Retinal fundus photograph. Camera: Remidio Fundus on Phone. 1659x2212.
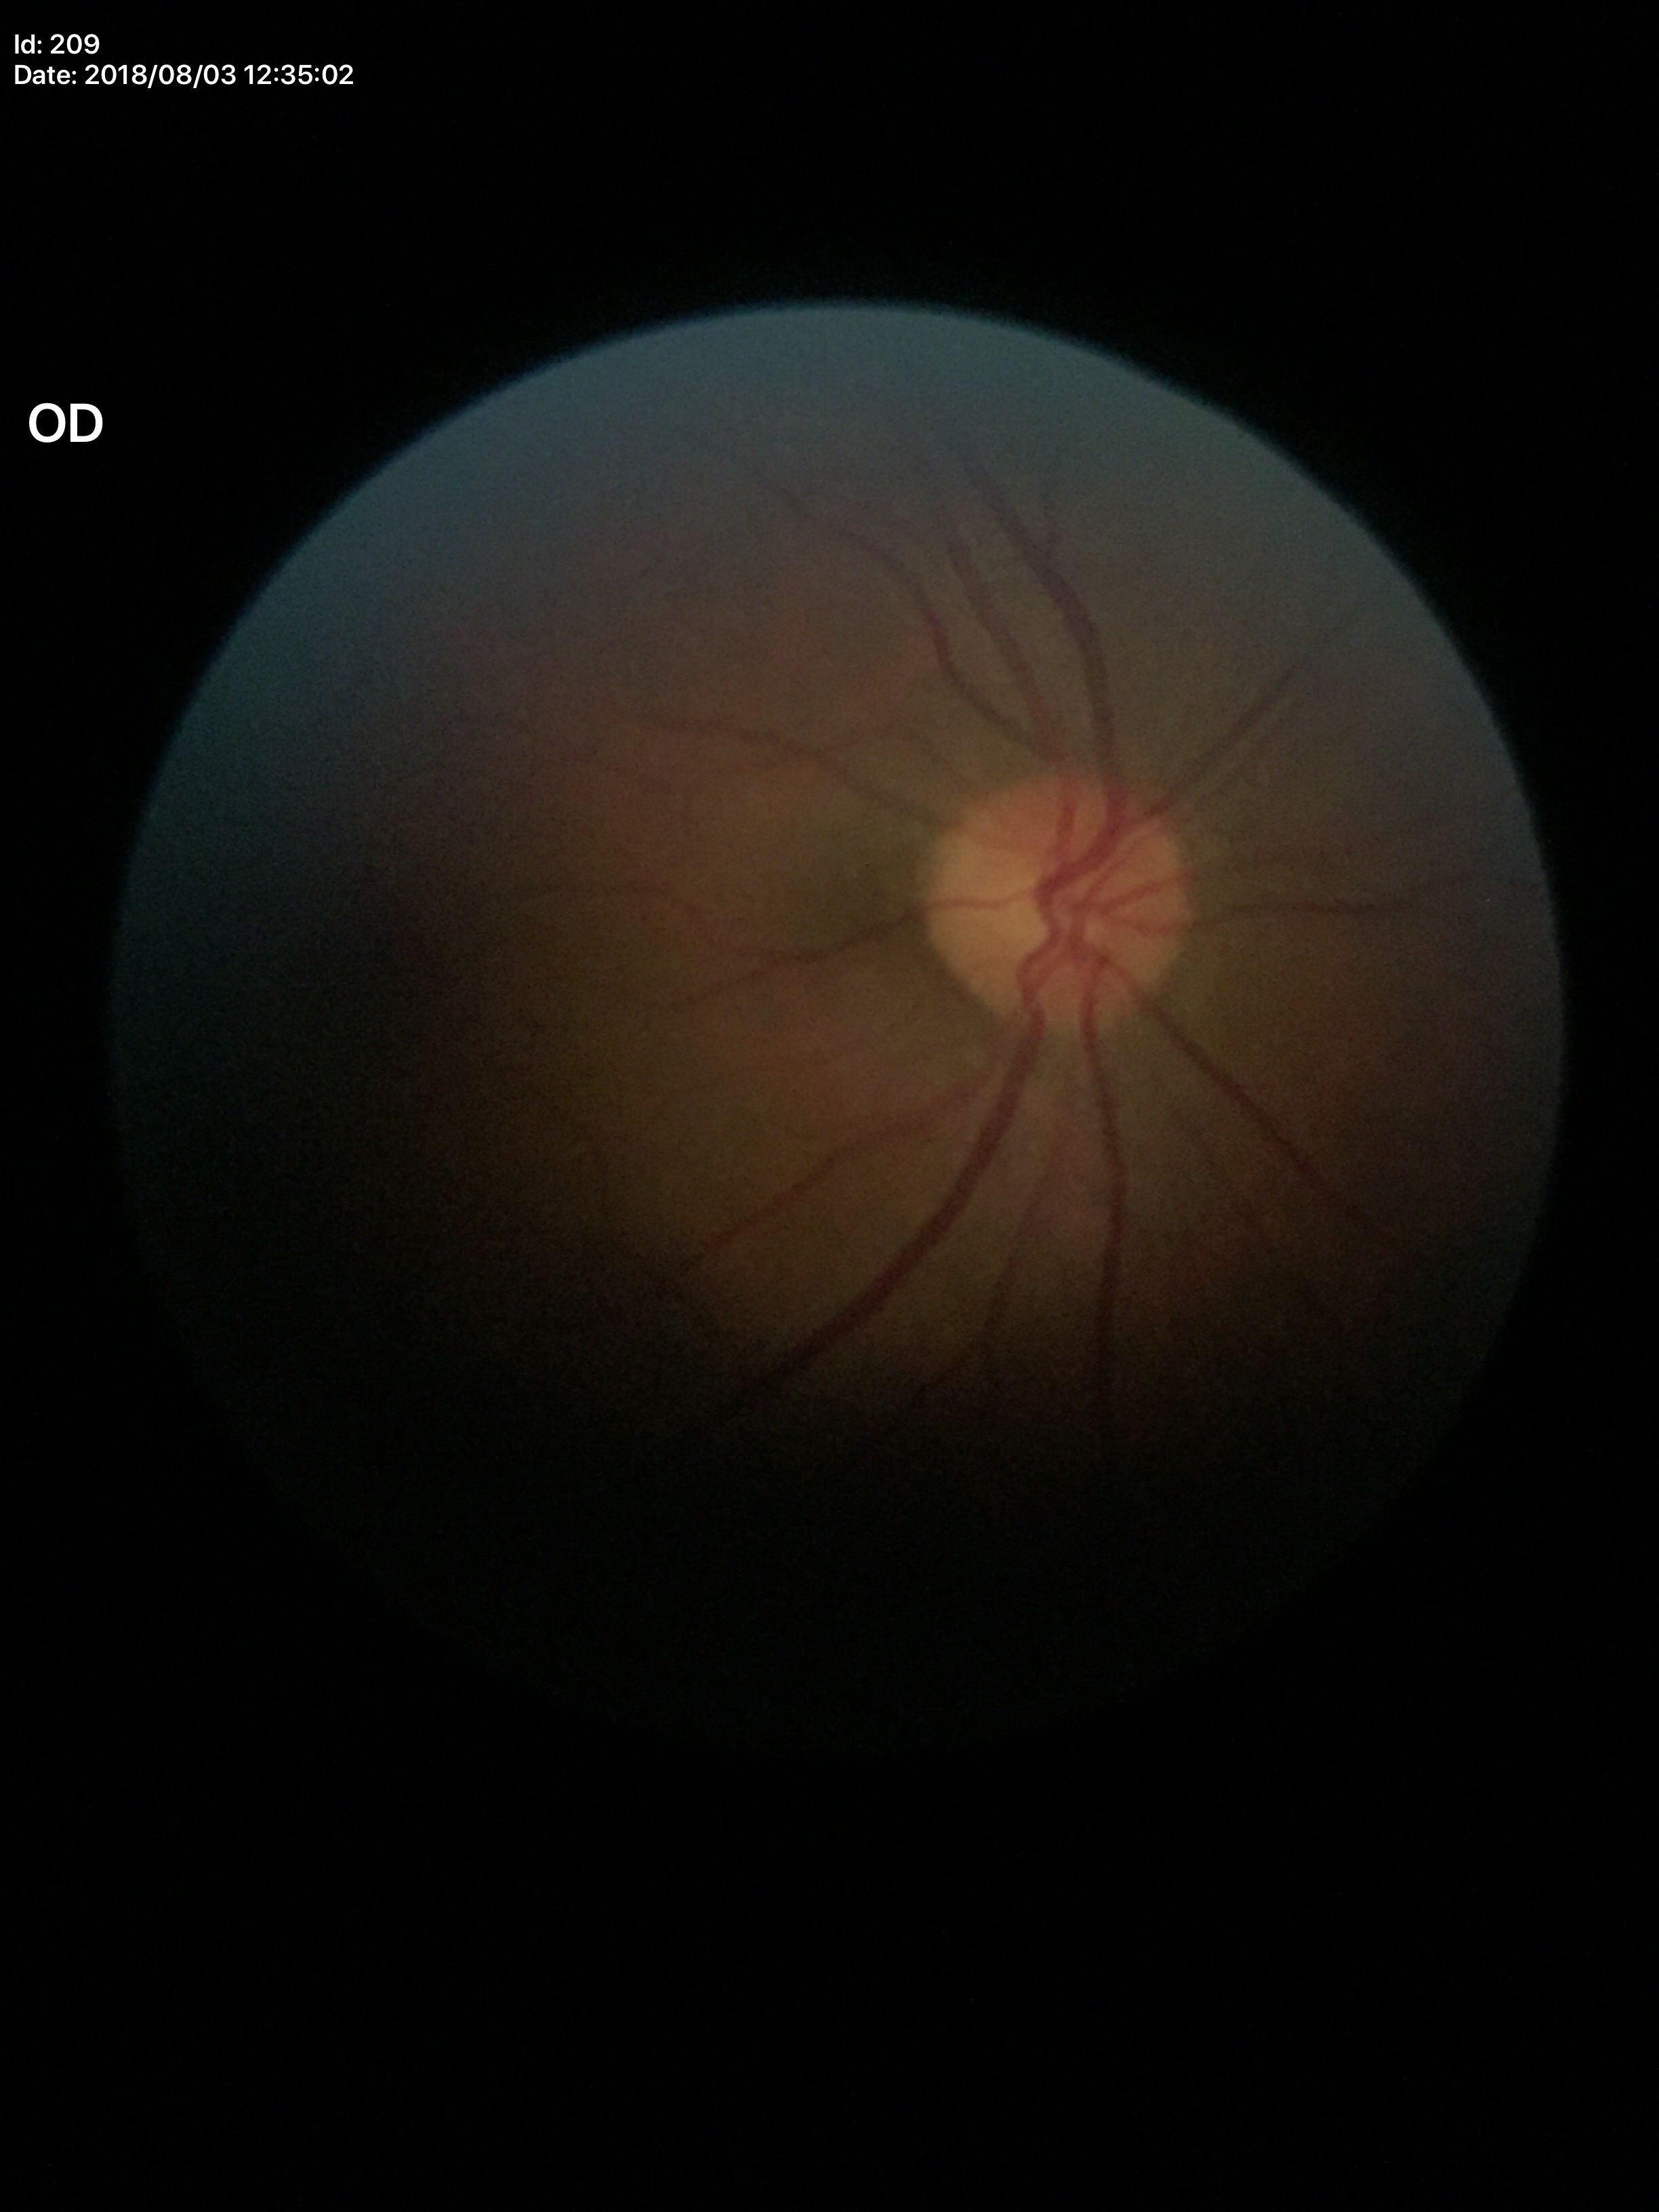
Optic disc analysis:
* Glaucoma evaluation — not suspect
* area cup-to-disc ratio — 0.20
* horizontal CDR — 0.44
* vertical cup-to-disc ratio — 0.45